Retinal fundus photograph
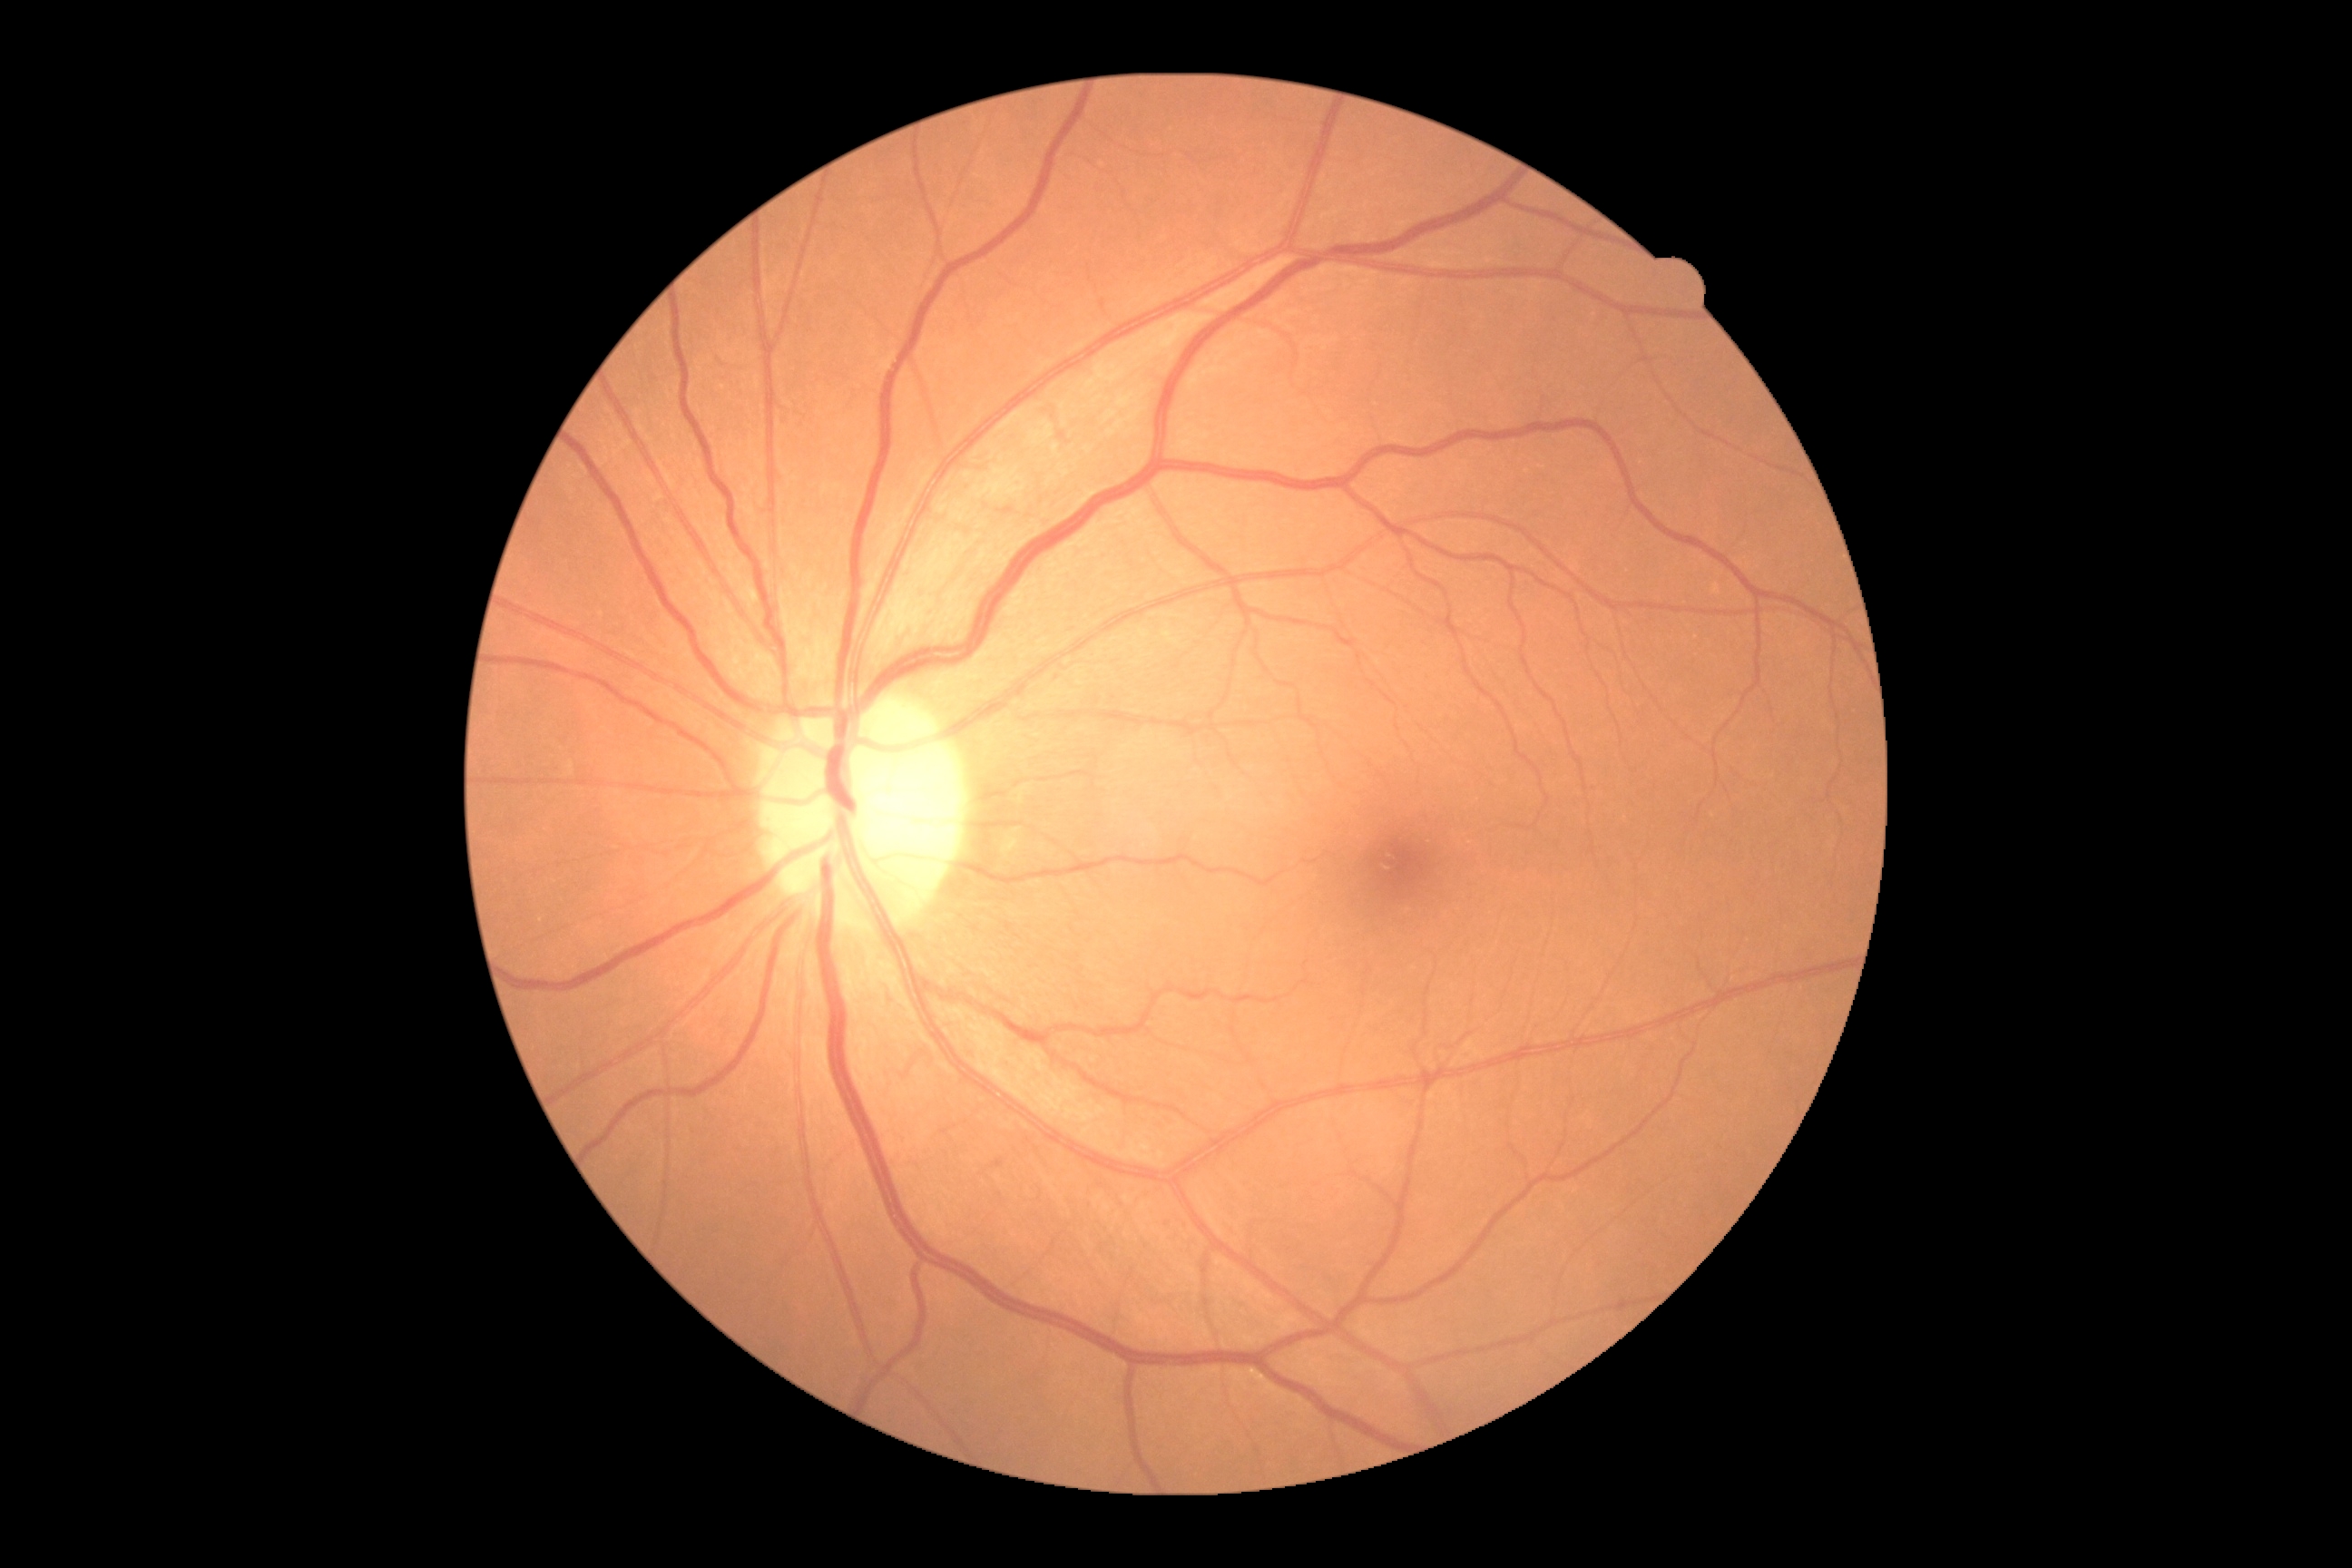
DR grade is 0 (no apparent retinopathy).